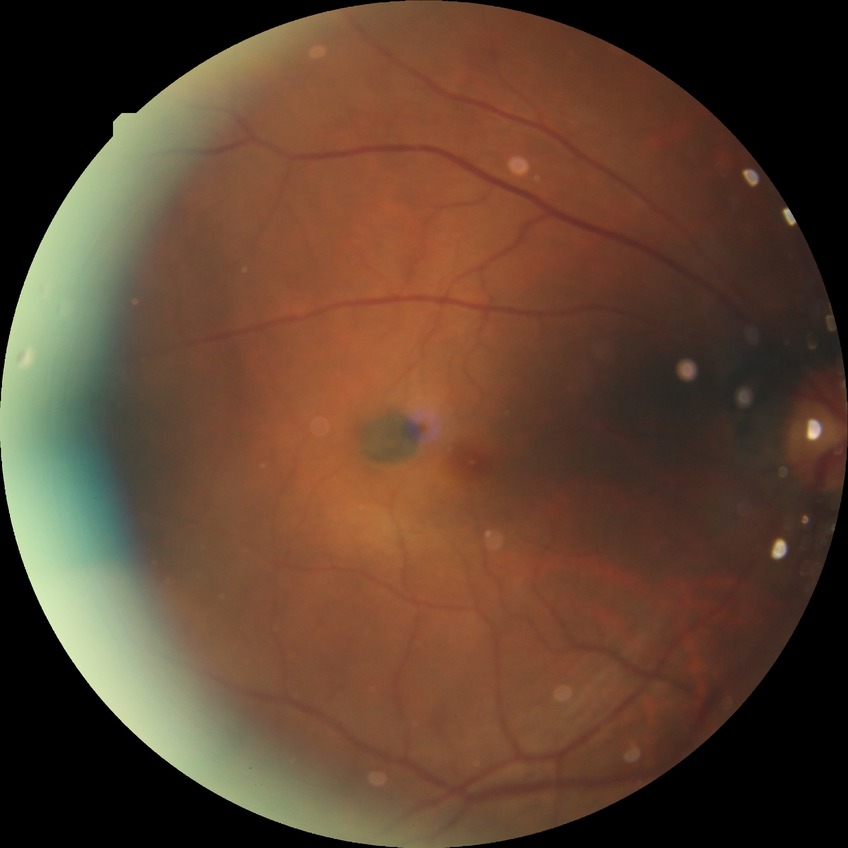
Diabetic retinopathy (DR): NDR (no diabetic retinopathy).